2212x1661 · centered on the optic disc · acquired with a Topcon TRC-NW400 — 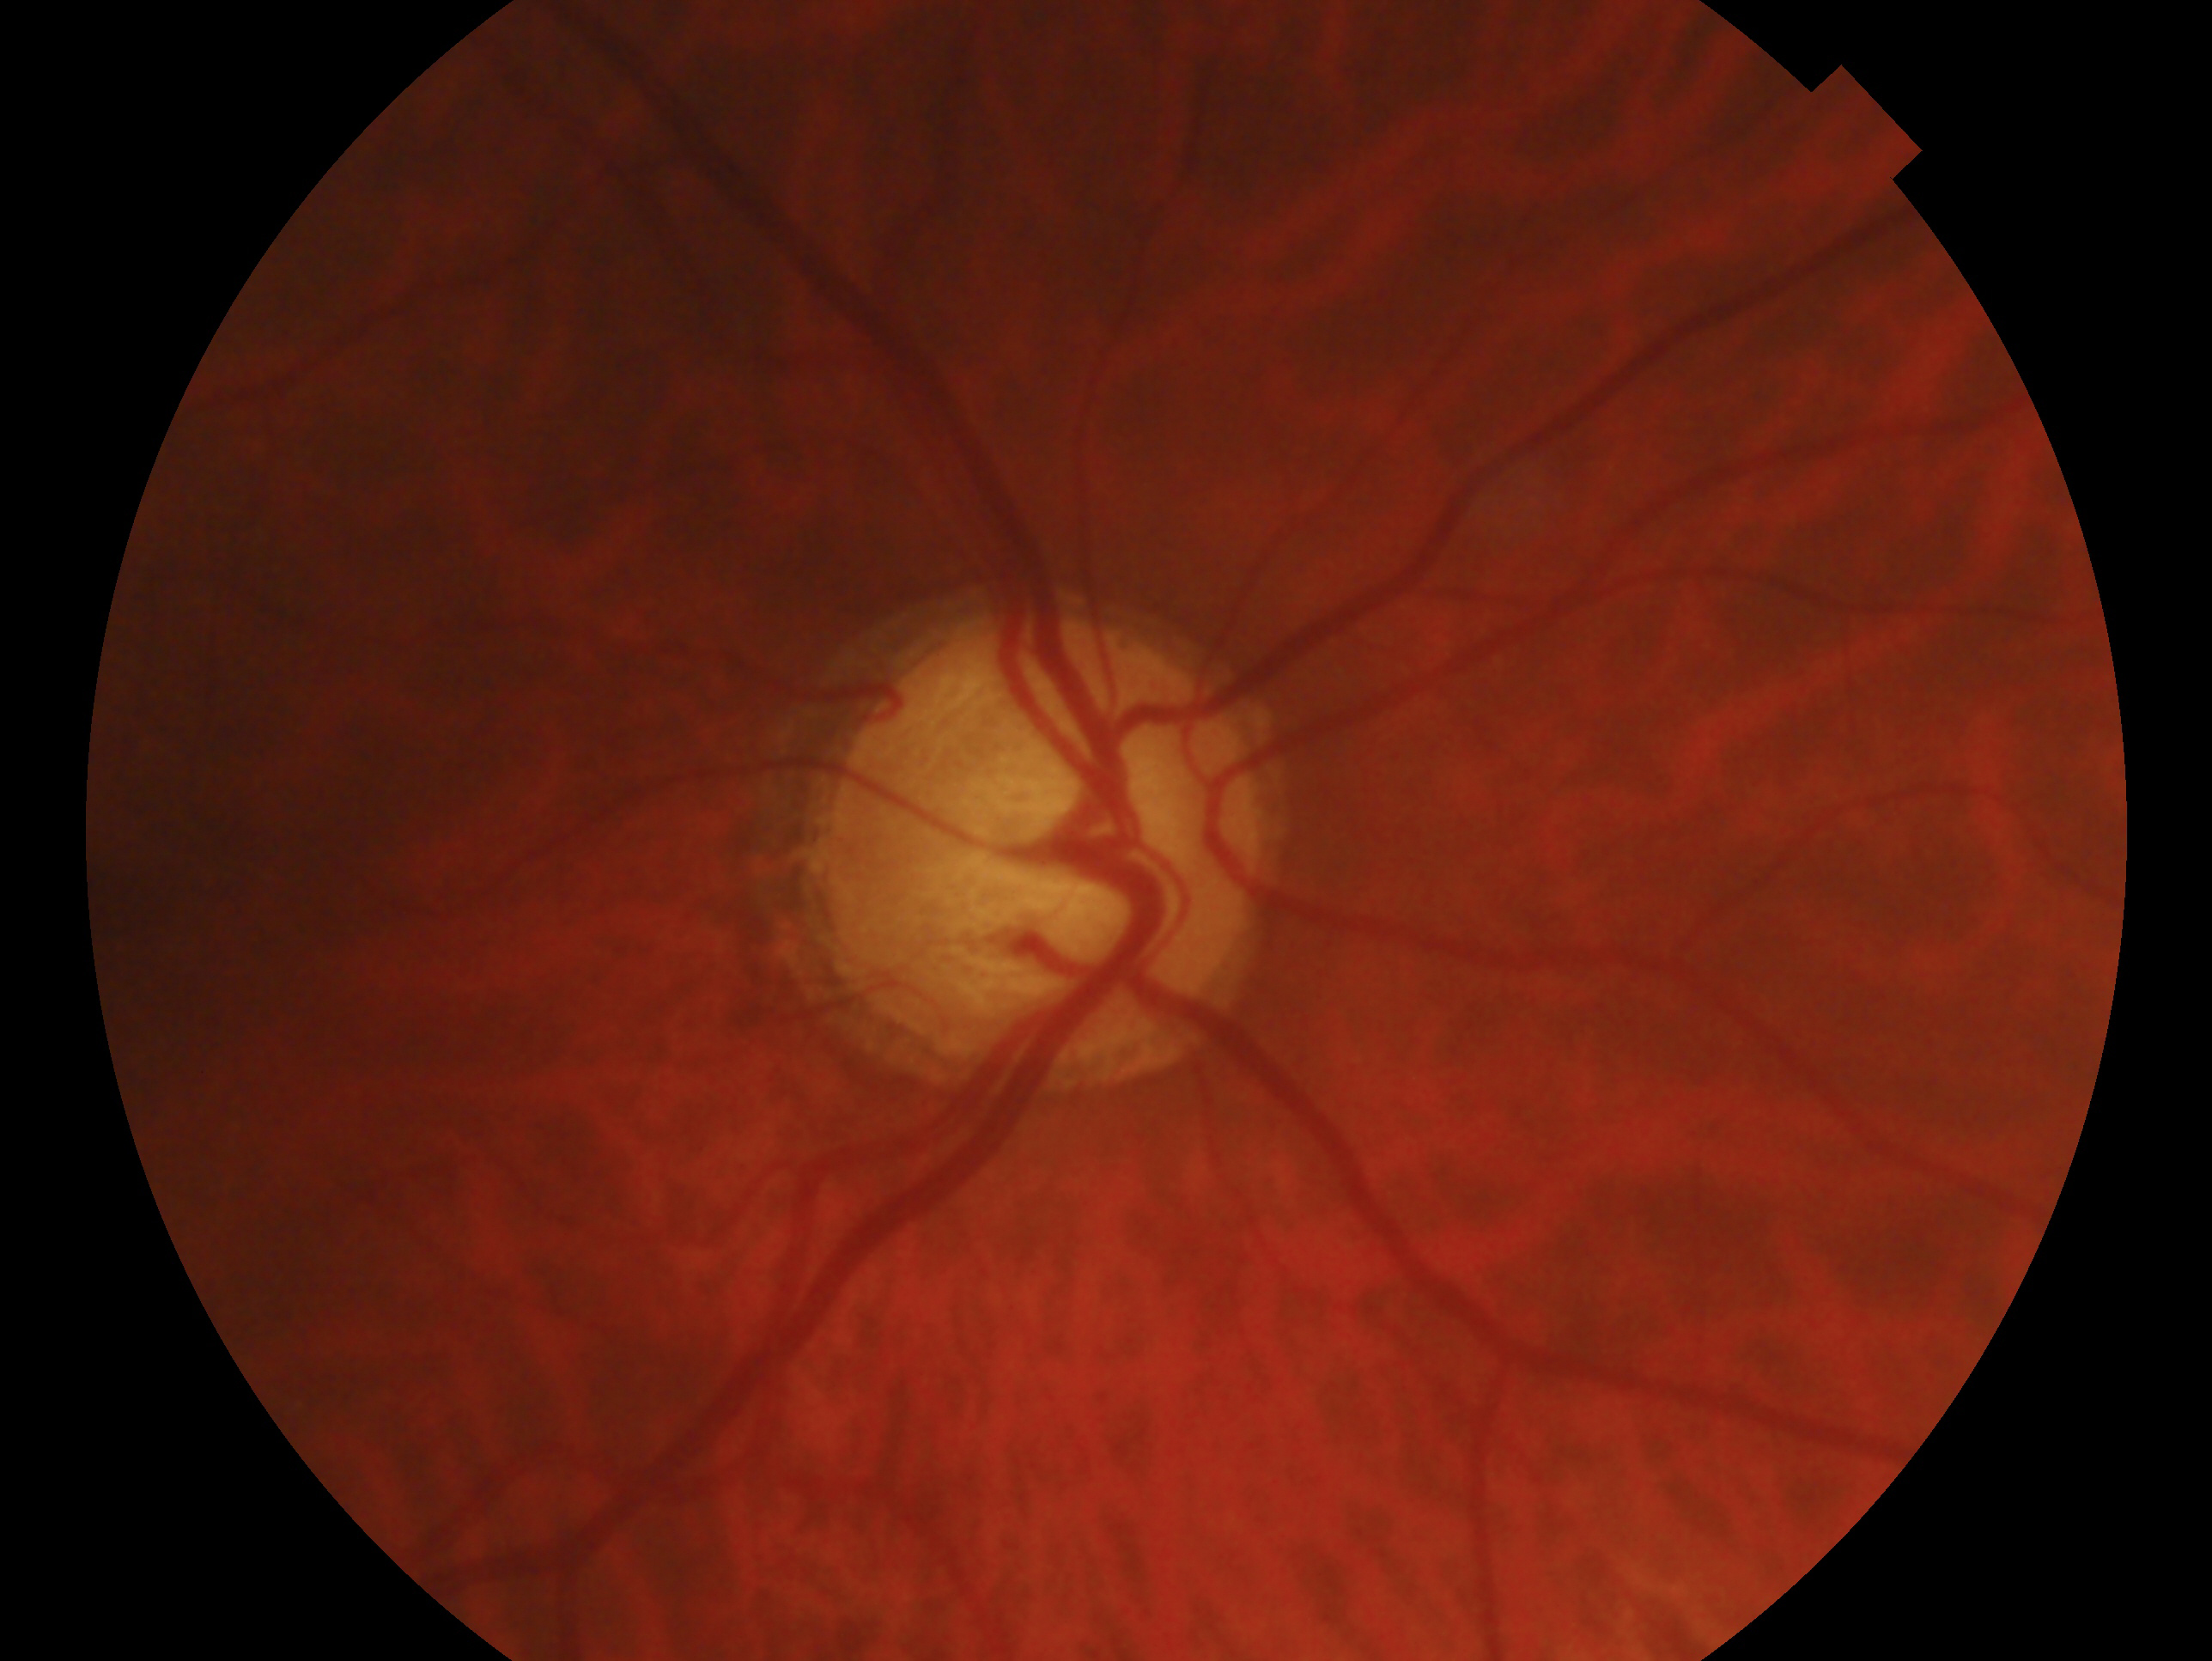
clinical classification=glaucomatous optic neuropathy | laterality=right eye.